45° field of view · color fundus photograph:
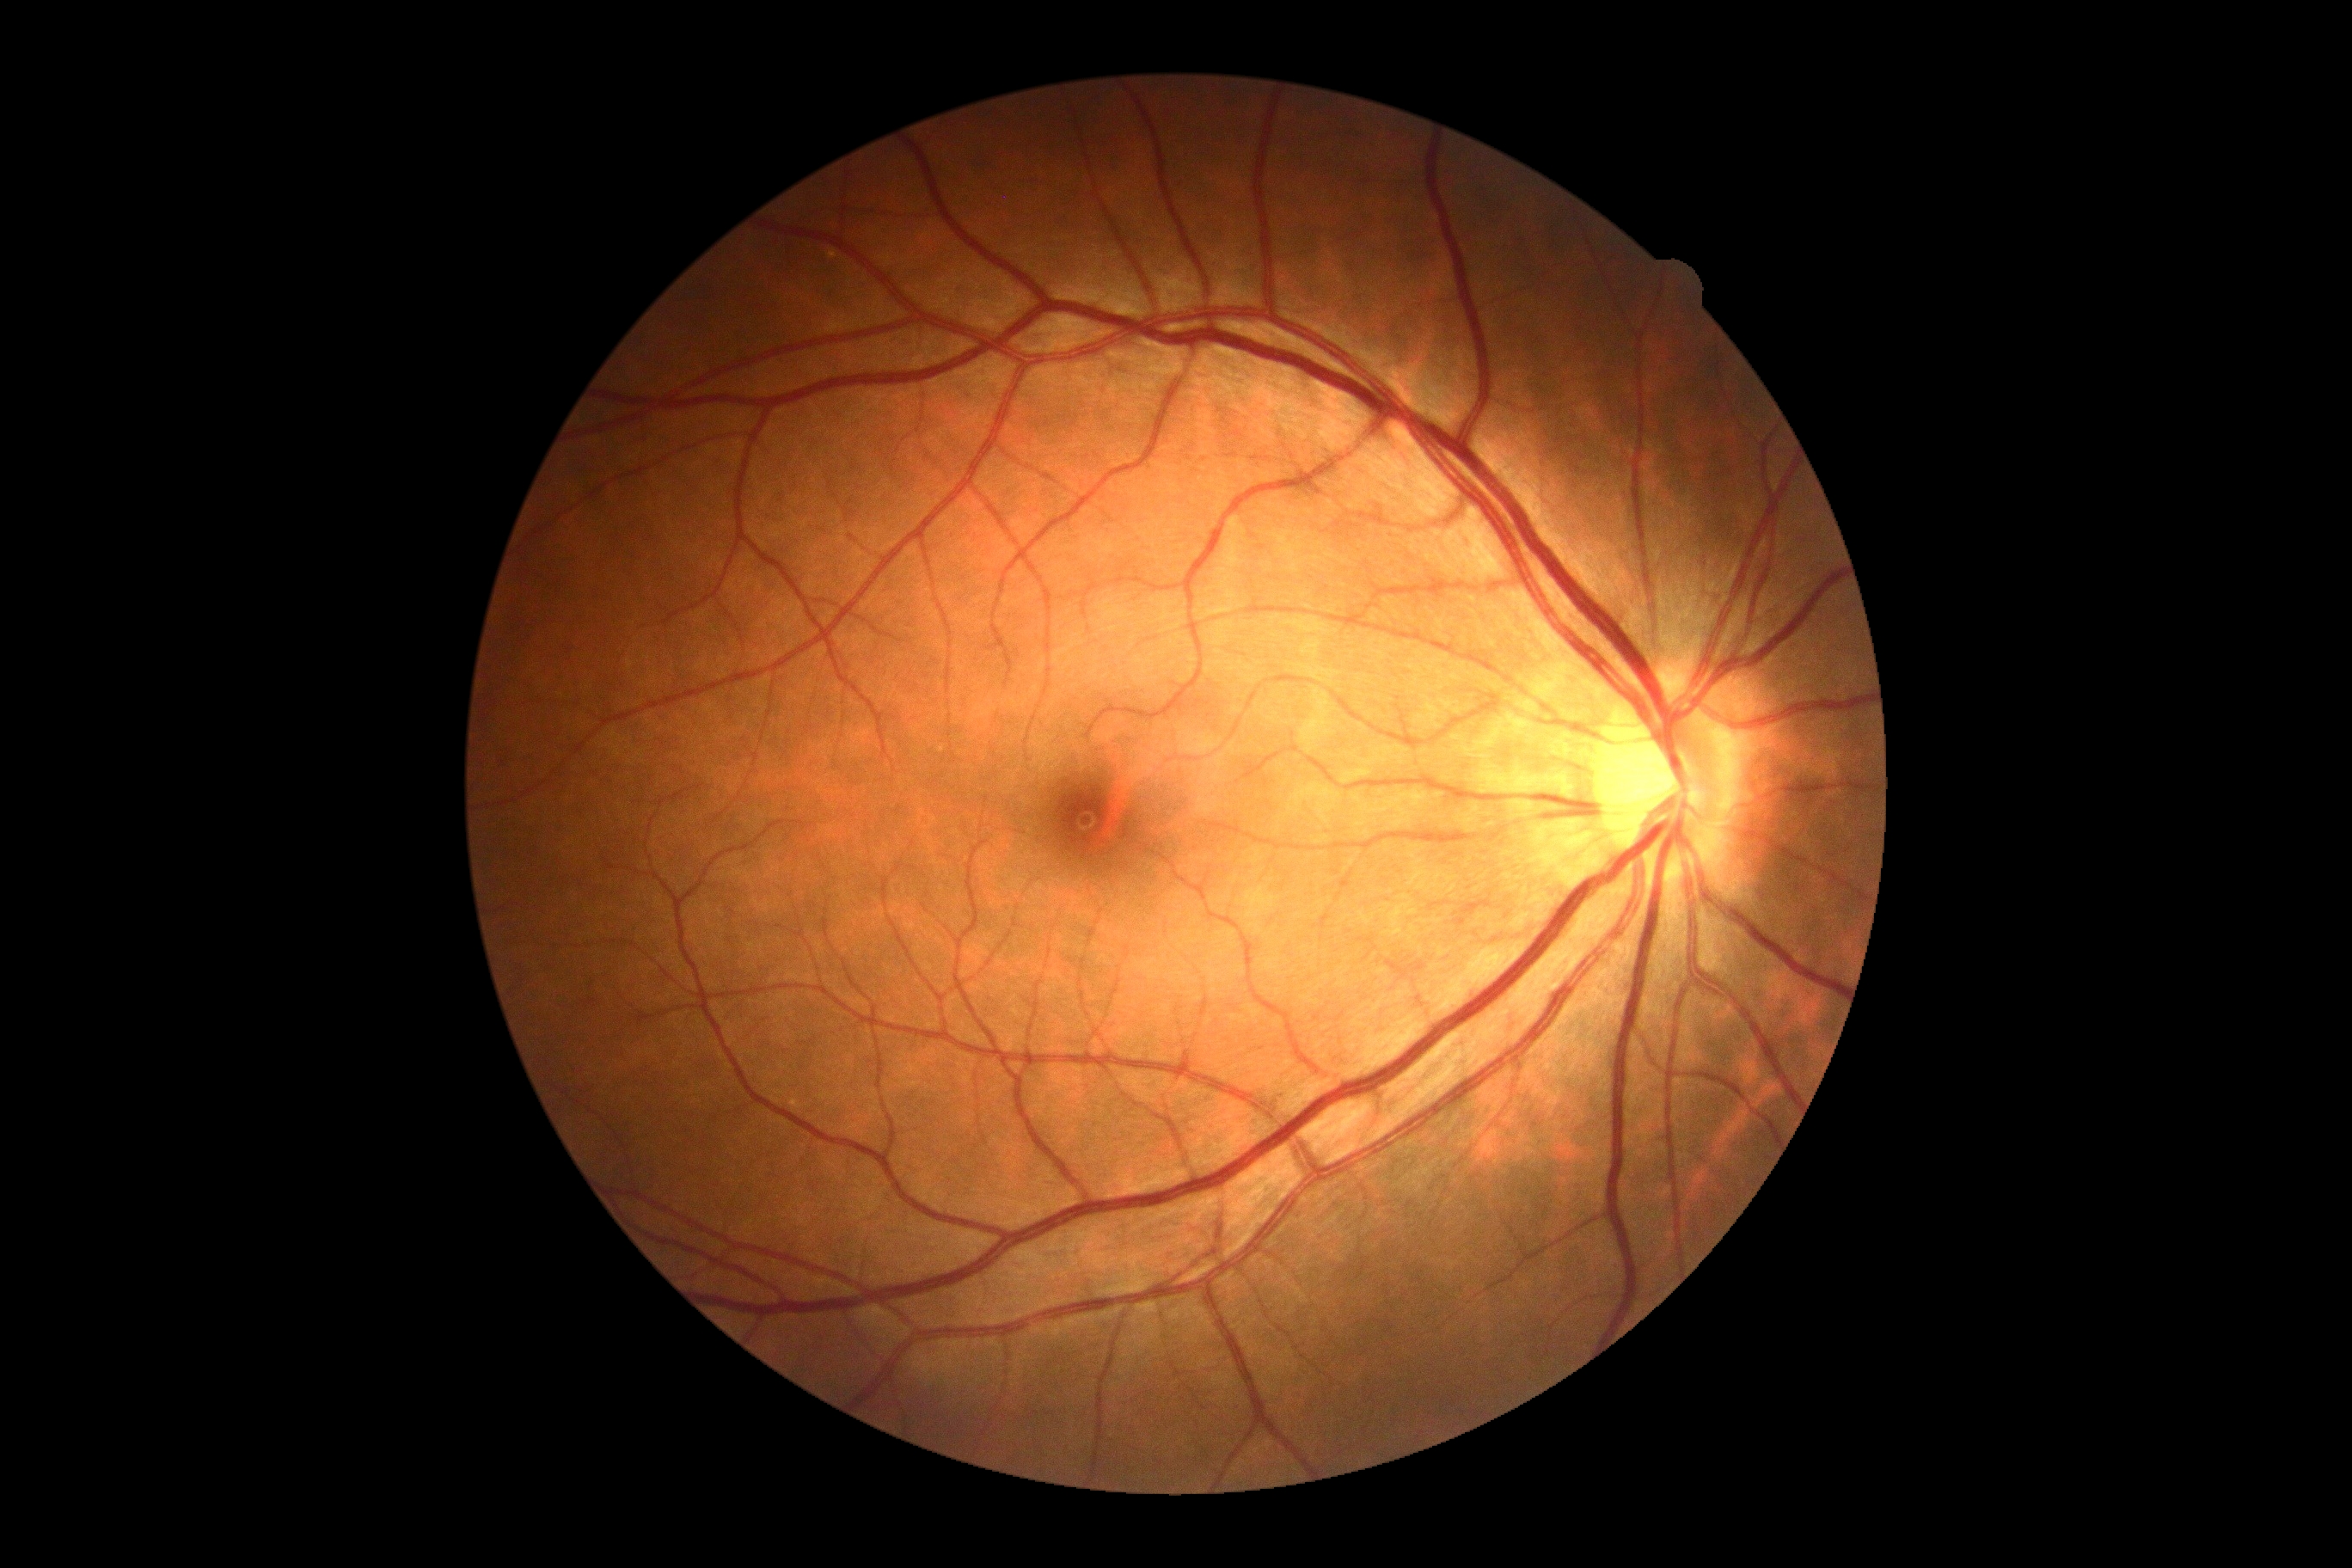

  dr_grade: grade 0 (no apparent retinopathy)